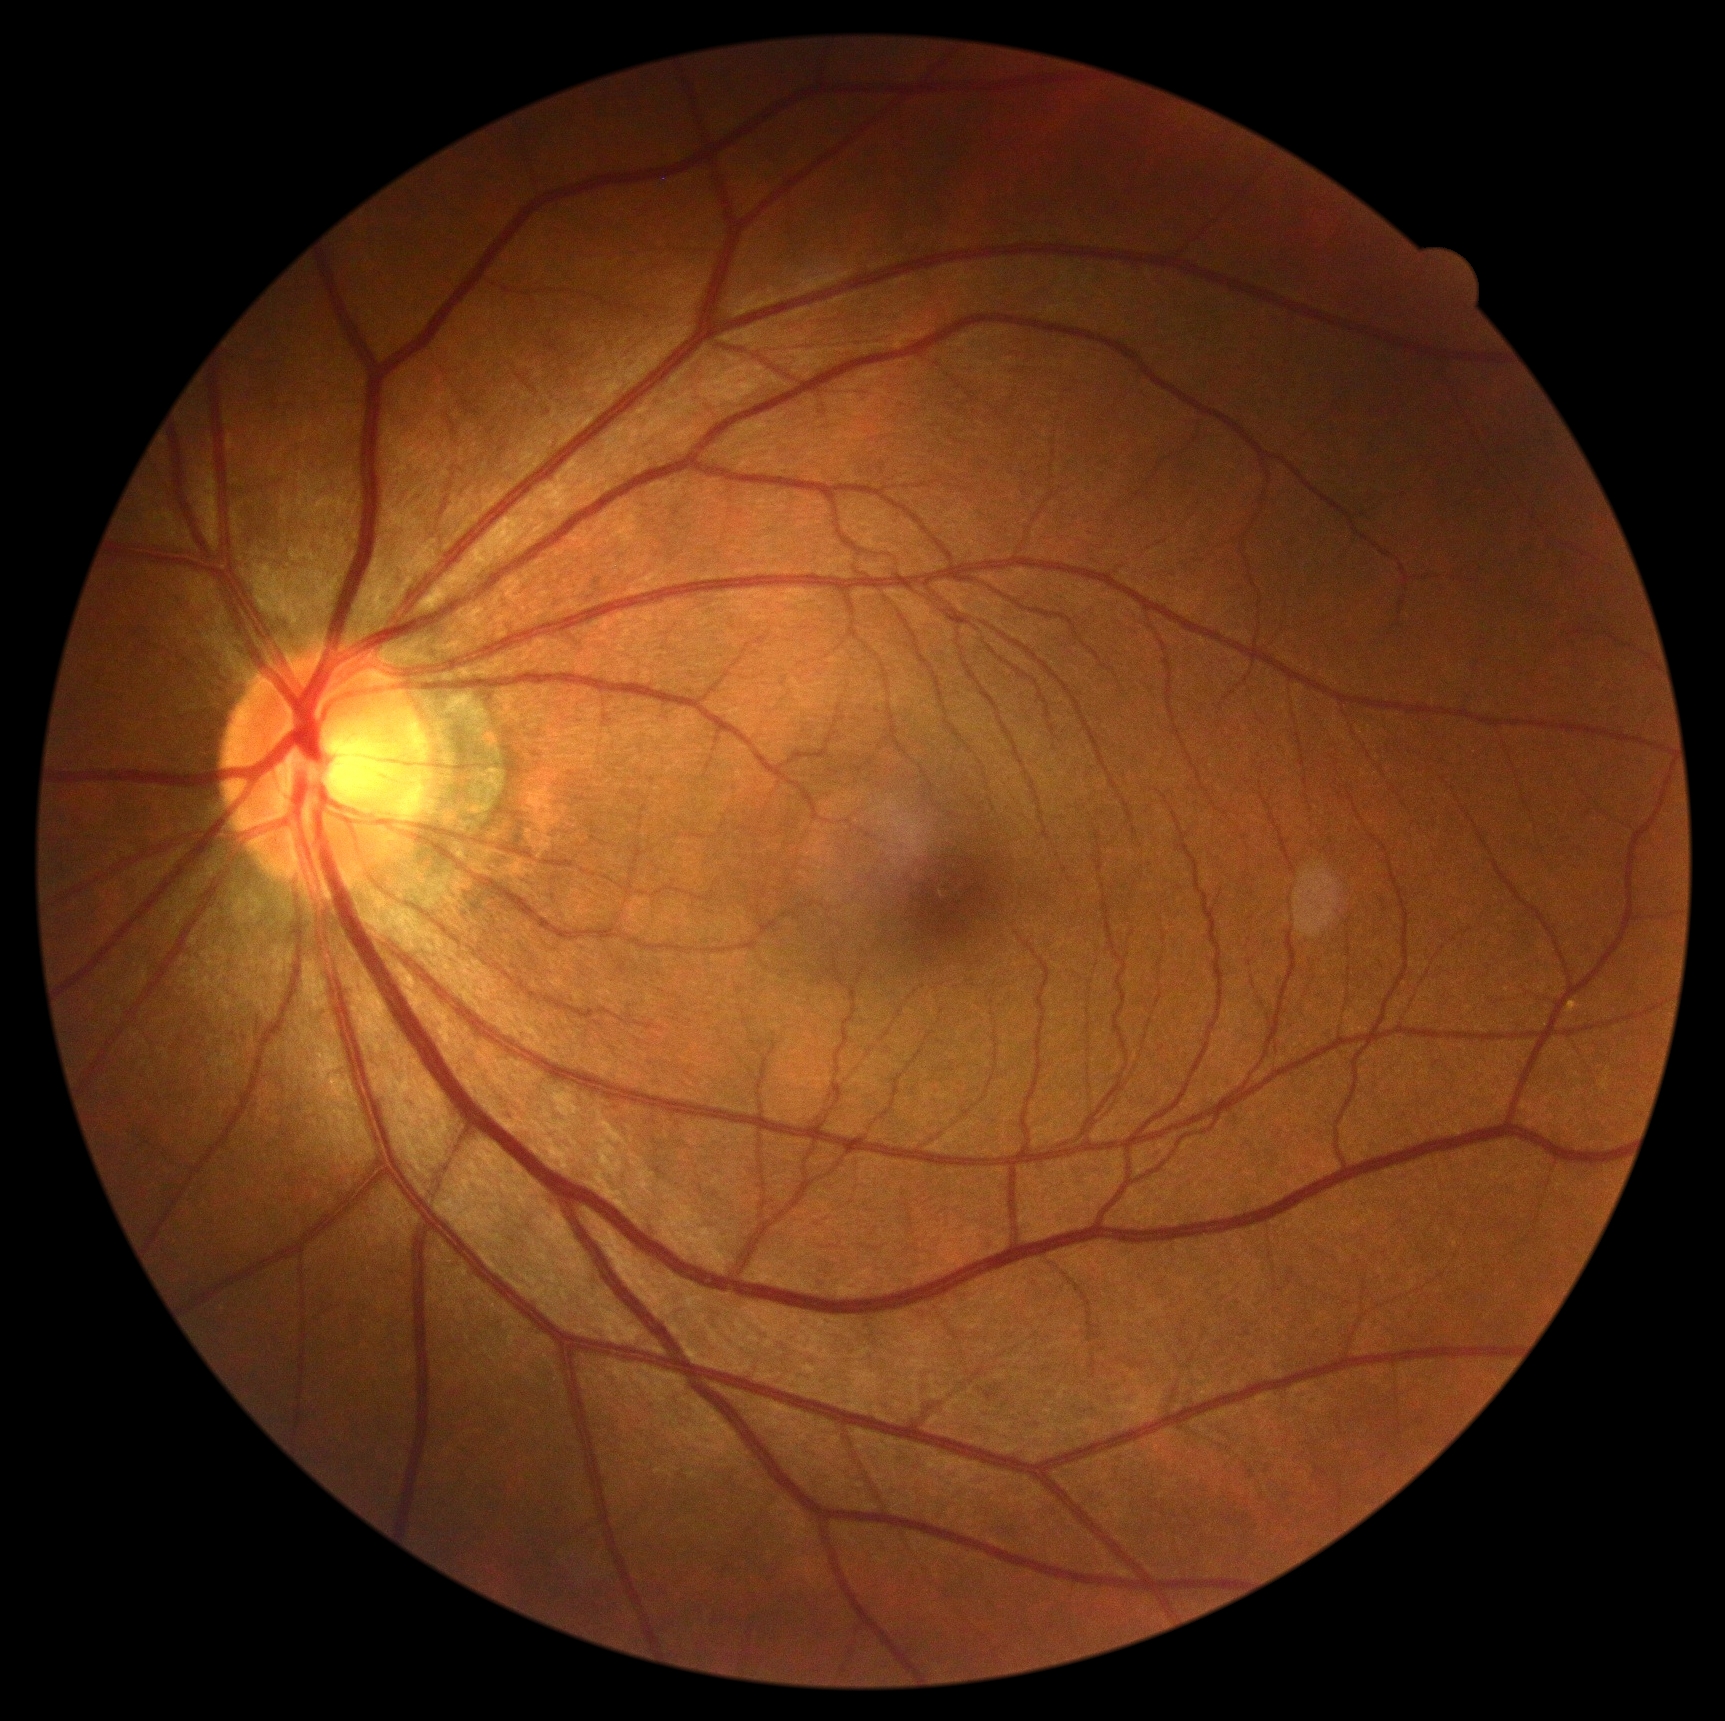 DR: grade 0 (no apparent retinopathy).